Modified Davis classification · nonmydriatic — 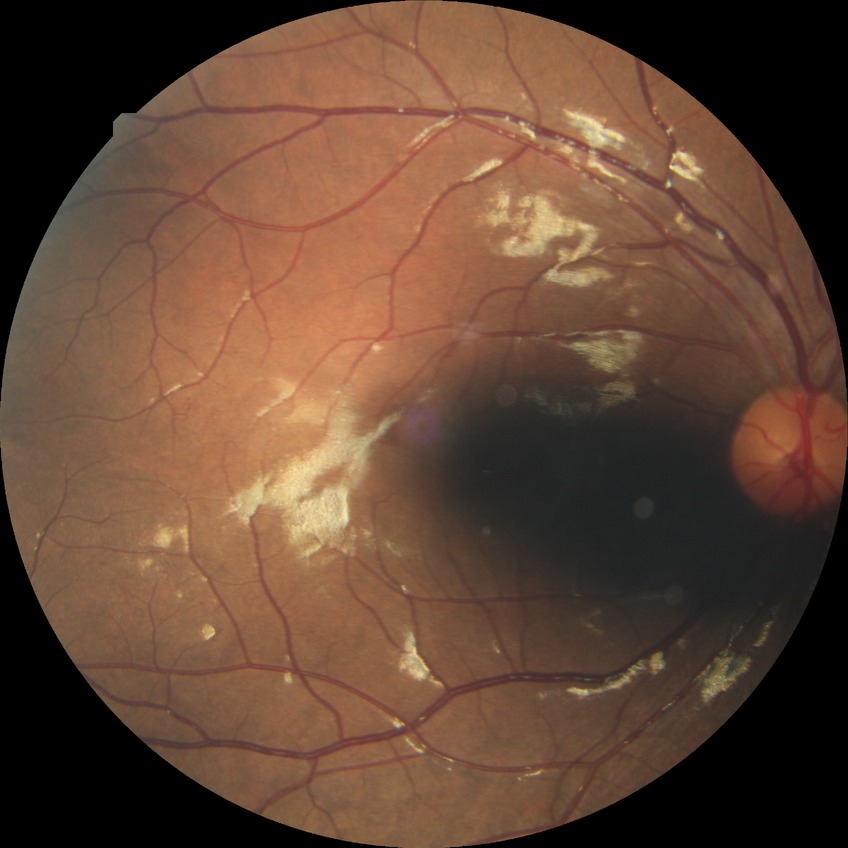

Diabetic retinopathy (DR): simple diabetic retinopathy (SDR). The retinopathy is classified as non-proliferative diabetic retinopathy.